Fundus photo — 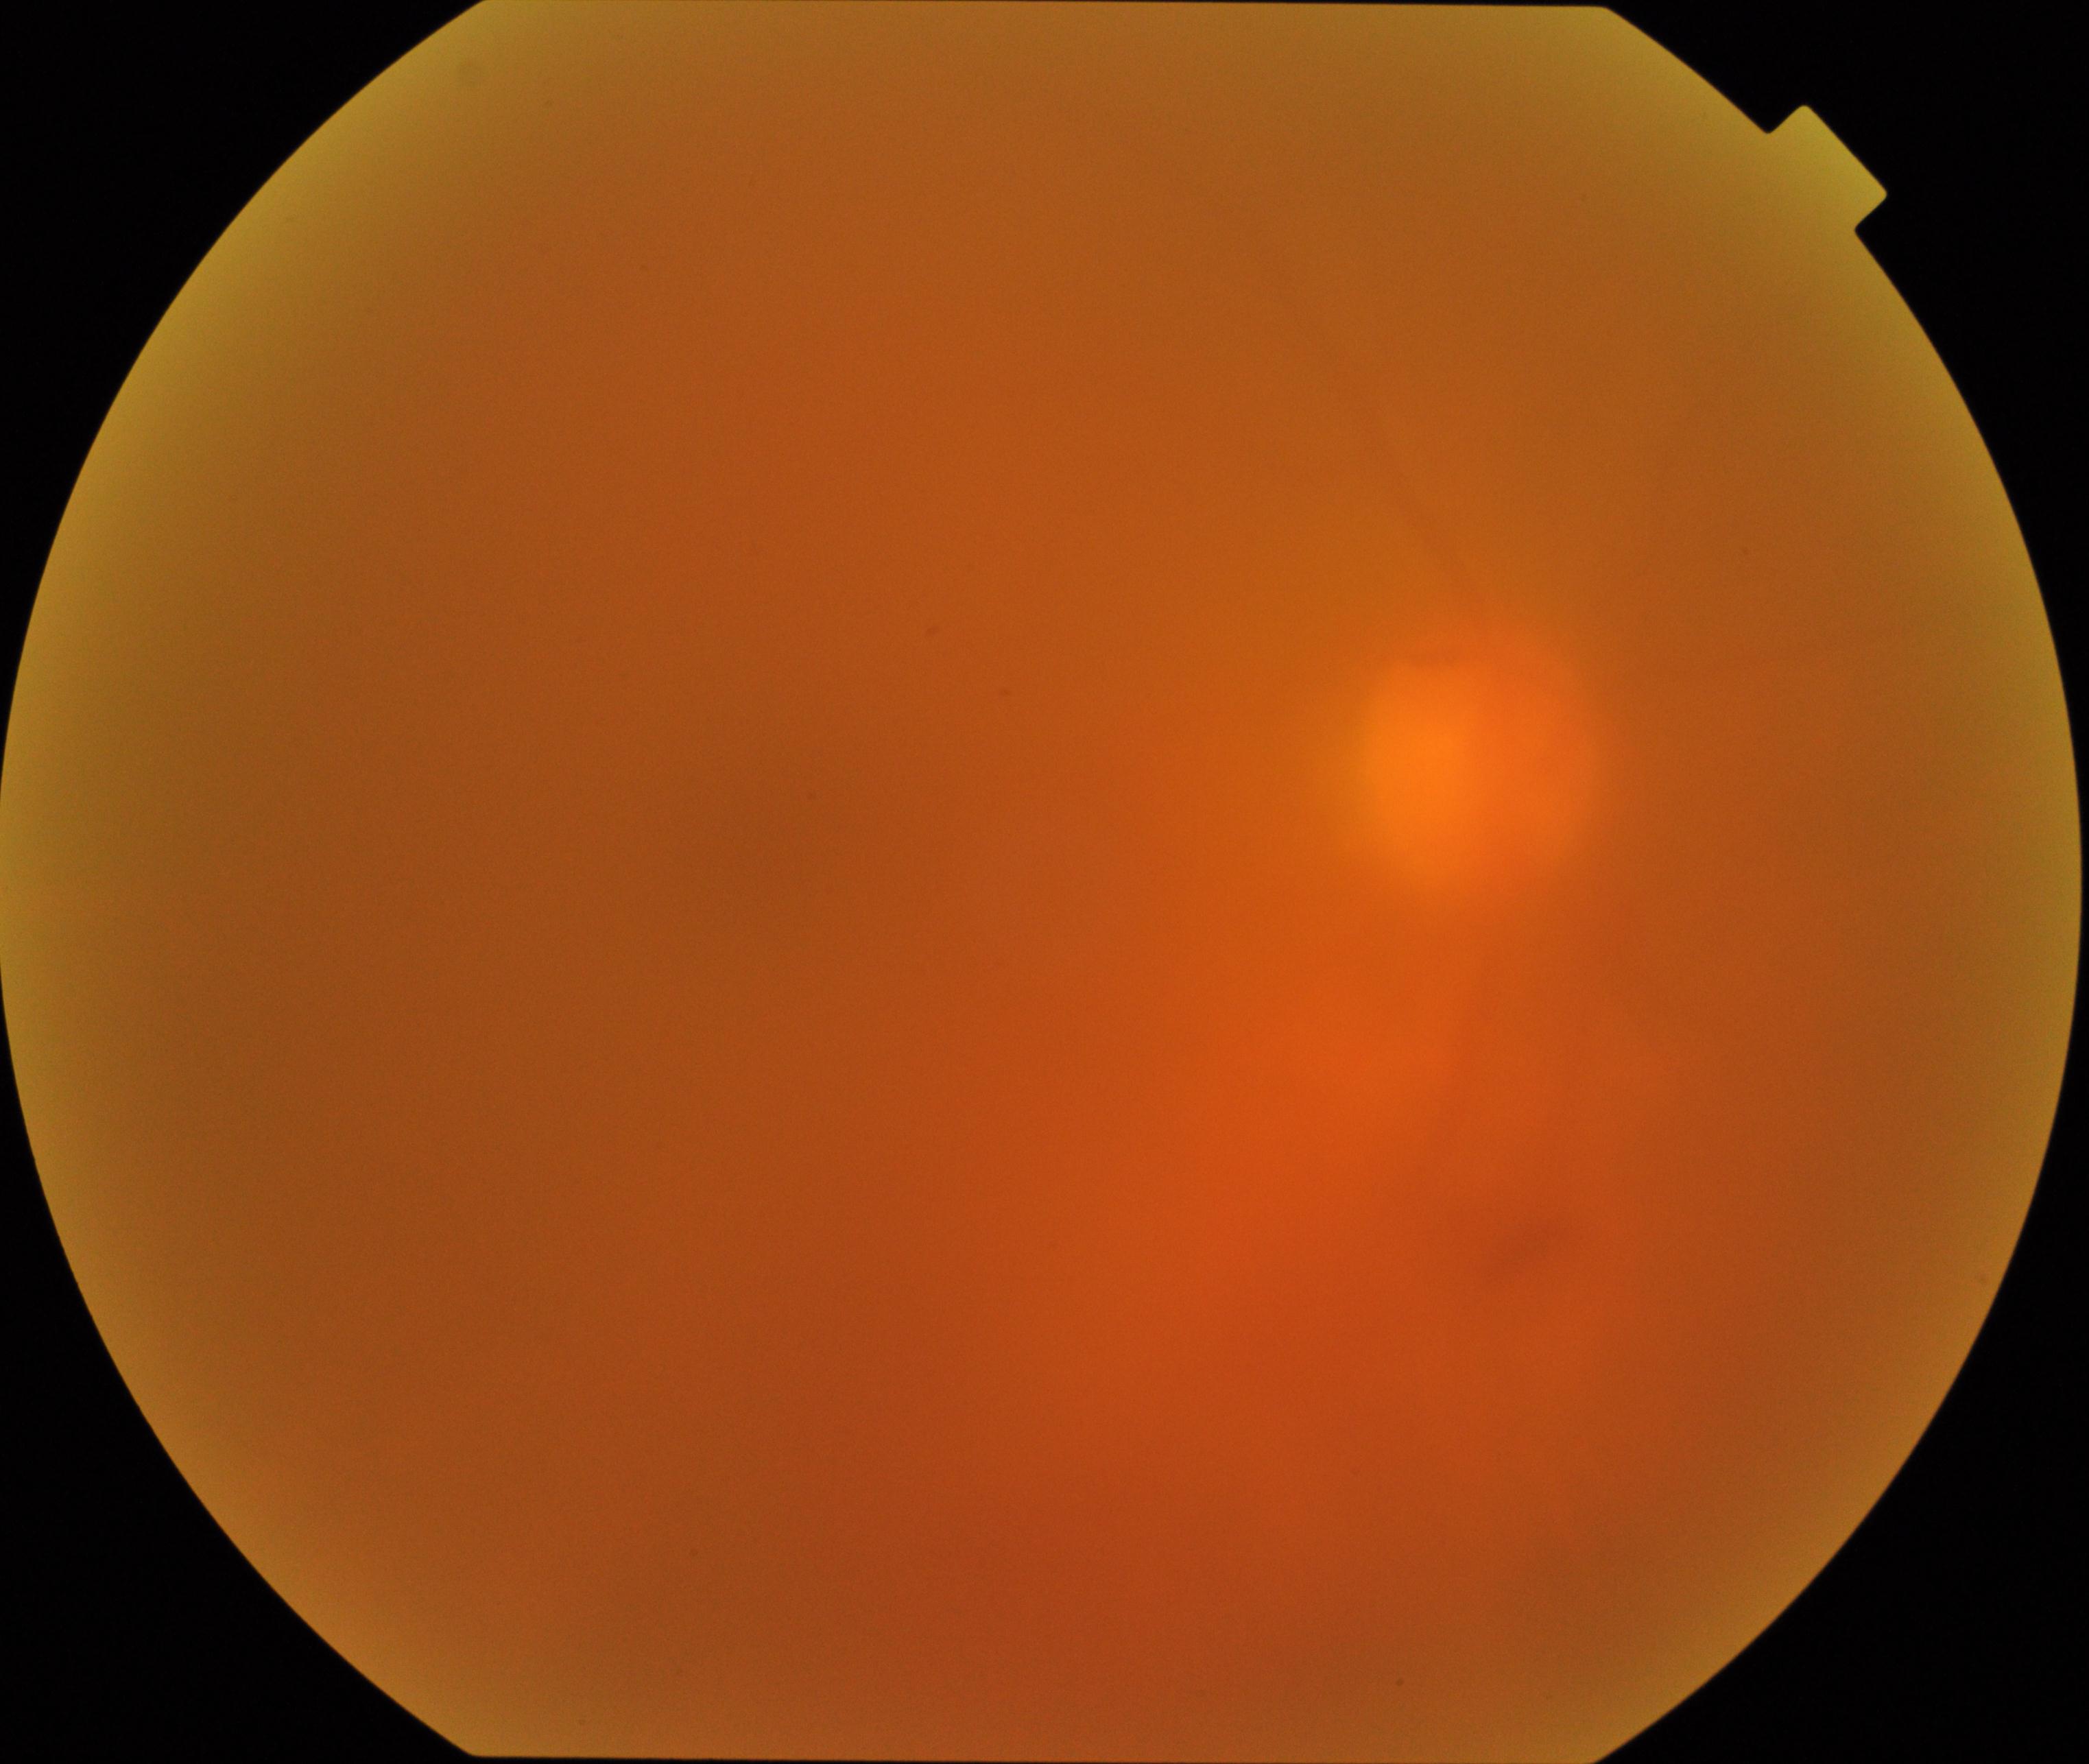

Image quality is poor; more than half the field is obscured. Proliferative diabetic retinopathy not identified in the visible portion.